Wide-field fundus image from infant ROP screening. 1440x1080.
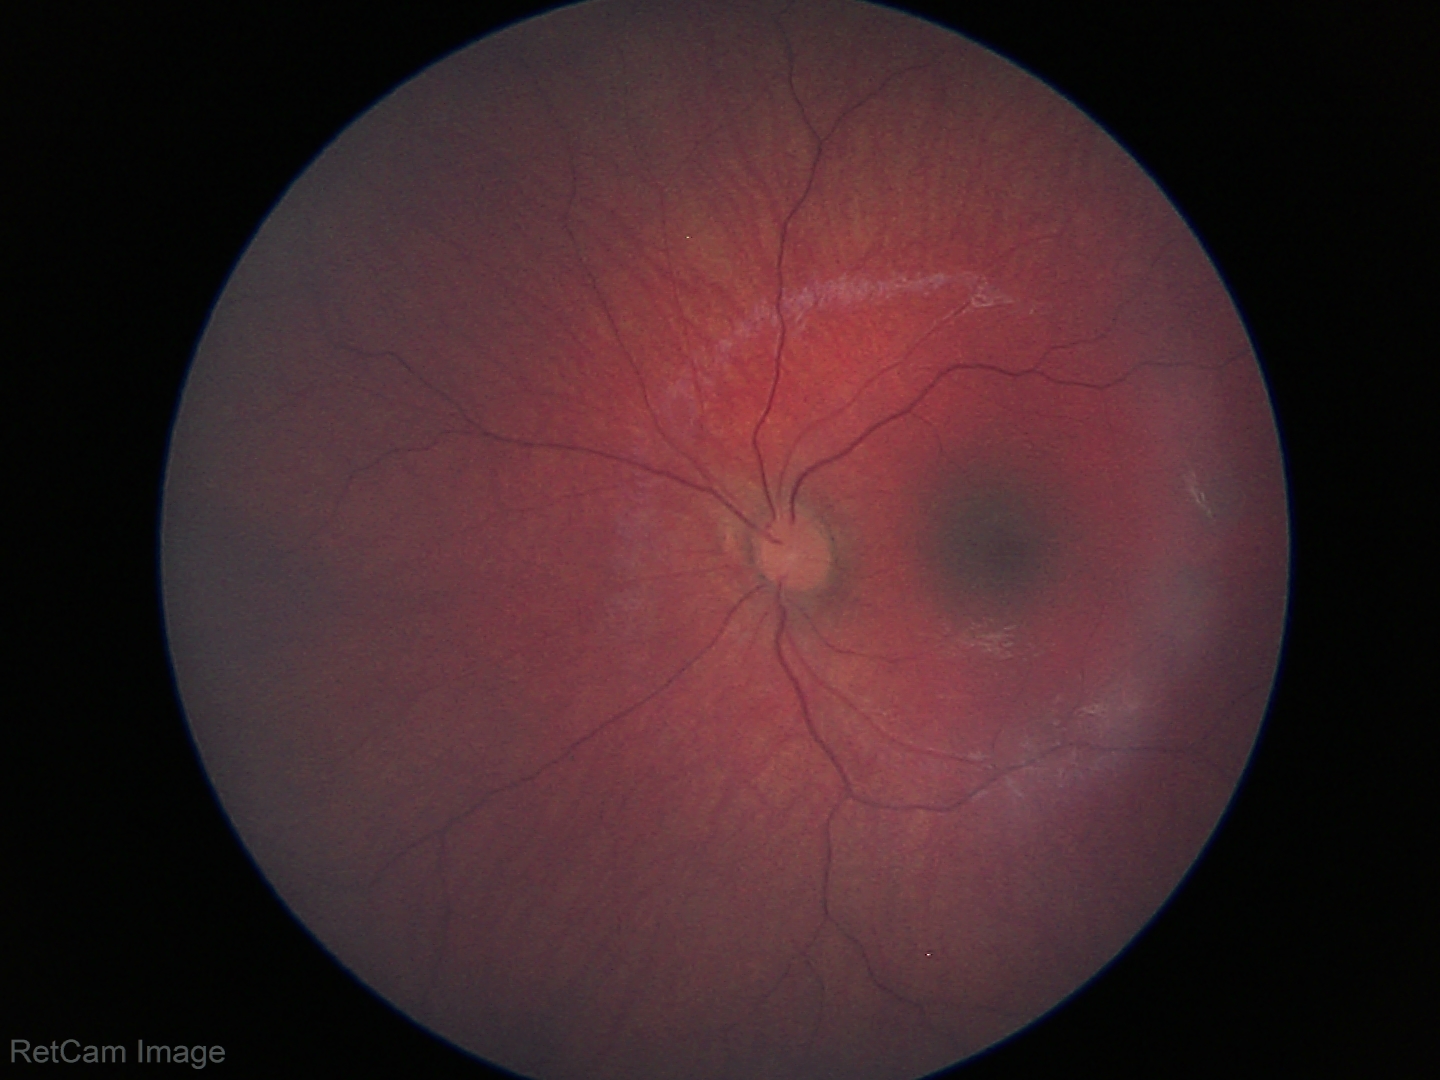
Examination with physiological retinal findings.